Wide-field contact fundus photograph of an infant.
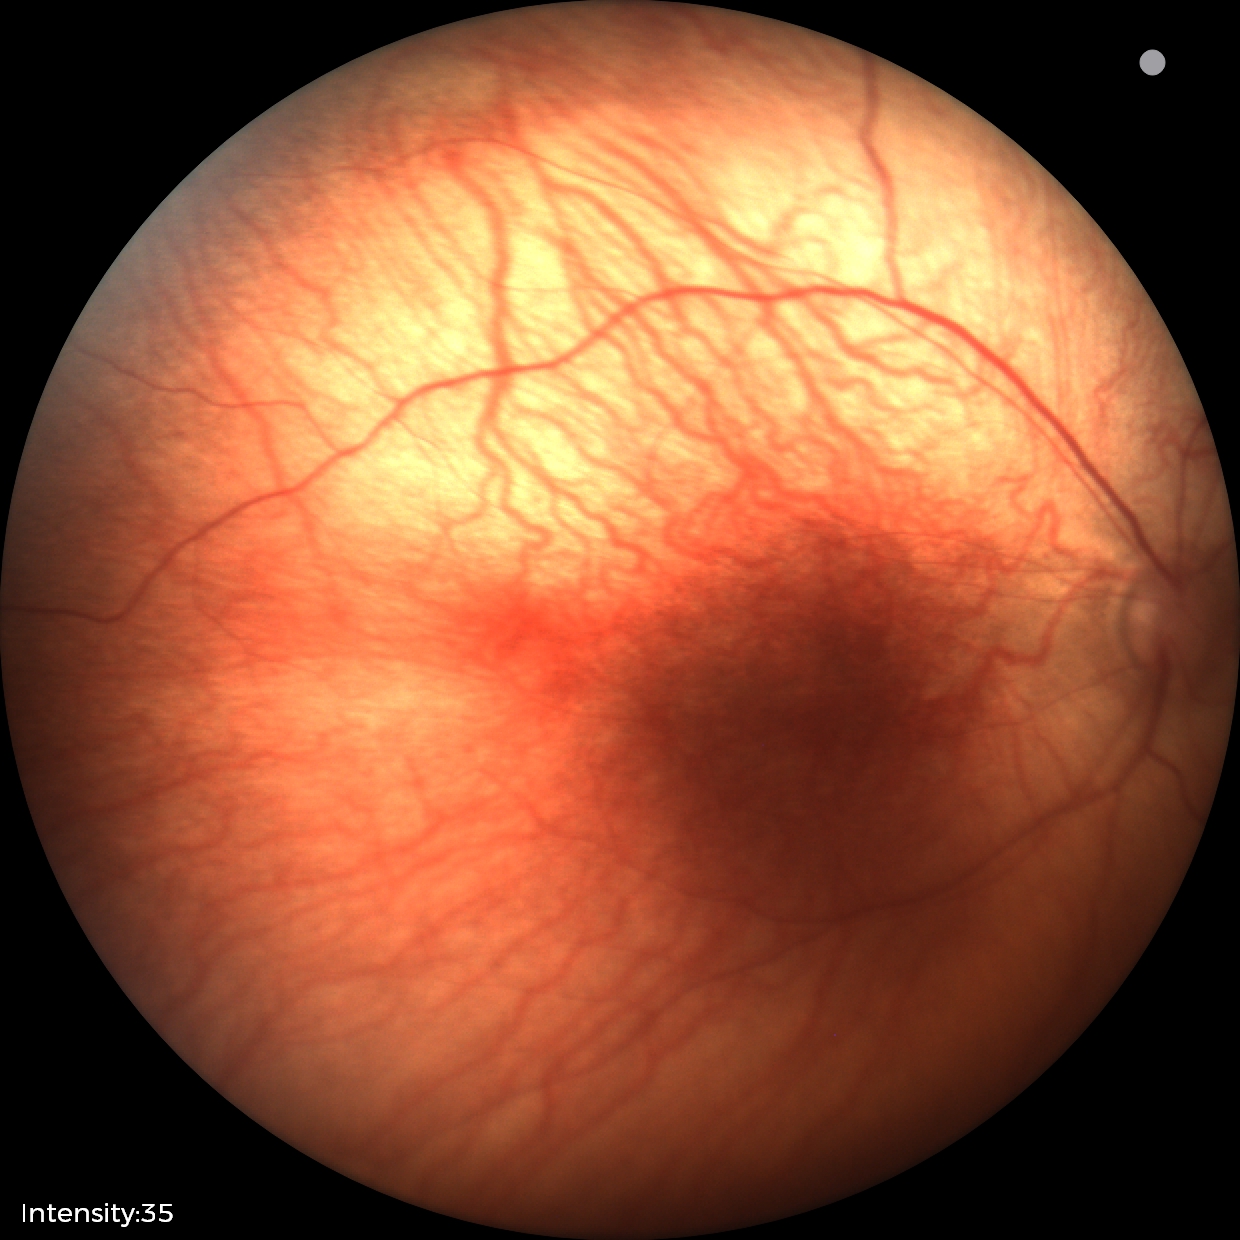
Screening examination diagnosed as physiological.